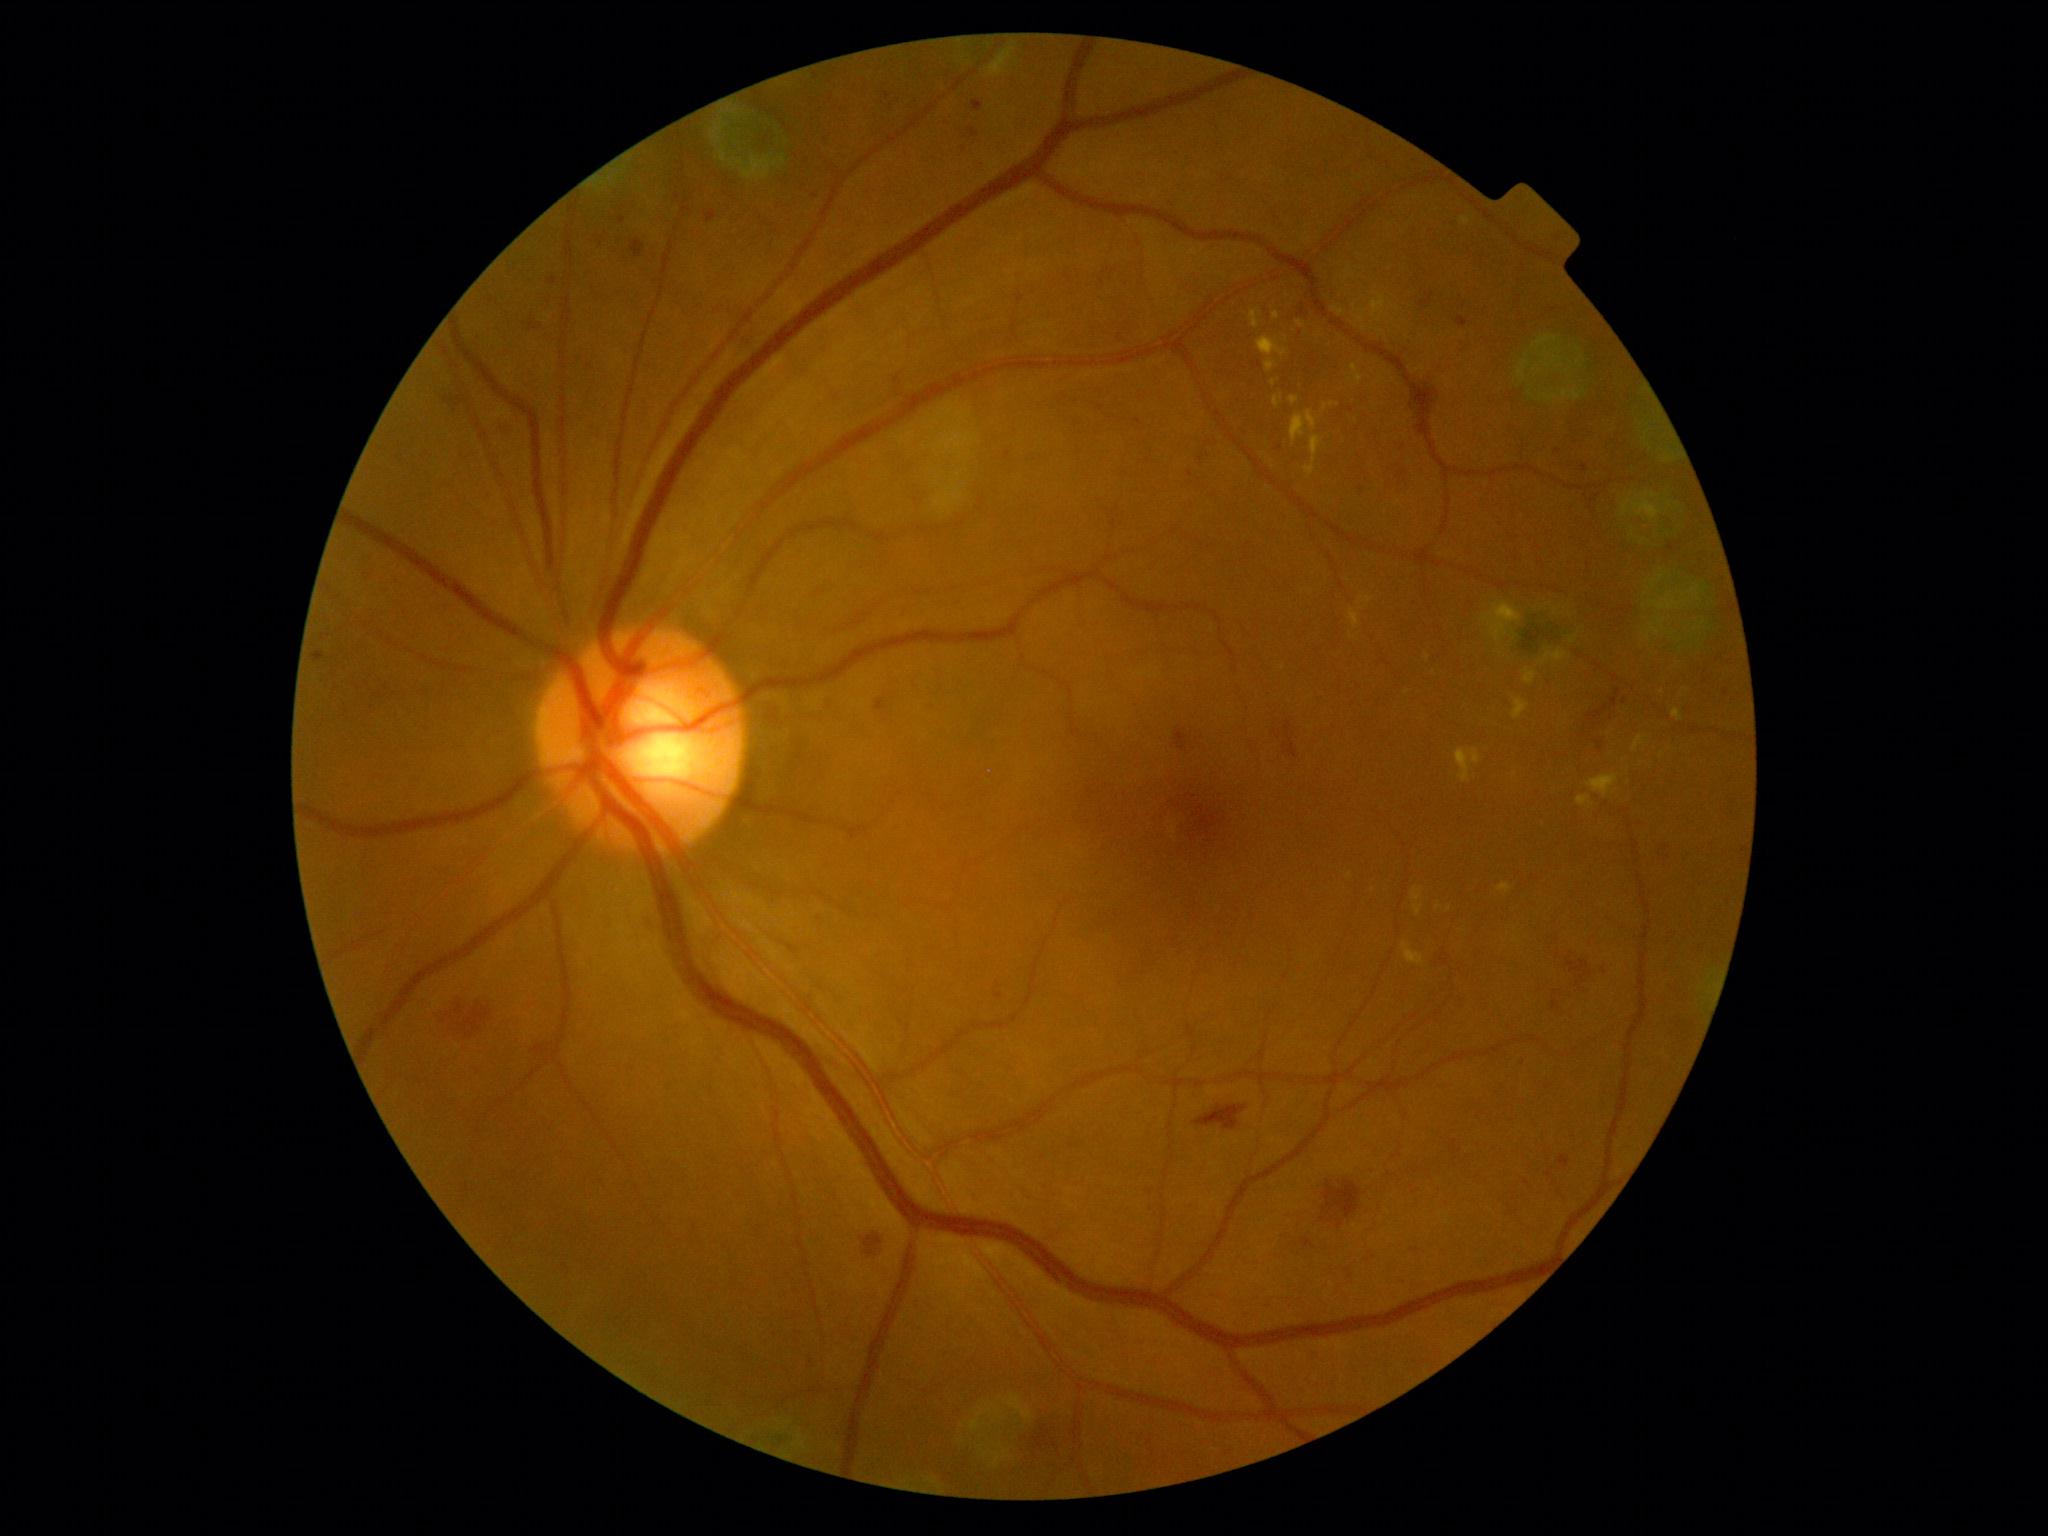

Diabetic retinopathy (DR): grade 2 (moderate NPDR); non-proliferative diabetic retinopathy. Hemorrhages (HEs) (partial list) at BBox(1330, 1216, 1334, 1224); BBox(445, 396, 465, 410); BBox(1553, 998, 1559, 1010); BBox(1587, 706, 1608, 727); BBox(1321, 1182, 1361, 1221); BBox(1337, 1219, 1343, 1228); BBox(1284, 722, 1298, 759); BBox(1568, 958, 1592, 984); BBox(1611, 690, 1621, 707); BBox(631, 240, 645, 258); BBox(1302, 1238, 1314, 1248). Hard exudates (EXs) (partial list) at BBox(1333, 307, 1345, 317); BBox(1350, 610, 1360, 630); BBox(1512, 699, 1529, 720); BBox(1403, 943, 1424, 965); BBox(1413, 887, 1423, 902); BBox(1497, 884, 1513, 894); BBox(1365, 597, 1374, 604); BBox(1586, 775, 1619, 798); BBox(1289, 397, 1299, 406); BBox(1576, 796, 1595, 810); BBox(1351, 364, 1363, 384); BBox(1291, 412, 1318, 445). EXs (small, approximate centers) near <pt>1274,383</pt>; <pt>1516,941</pt>; <pt>1449,910</pt>.